1960 x 1897 pixels — 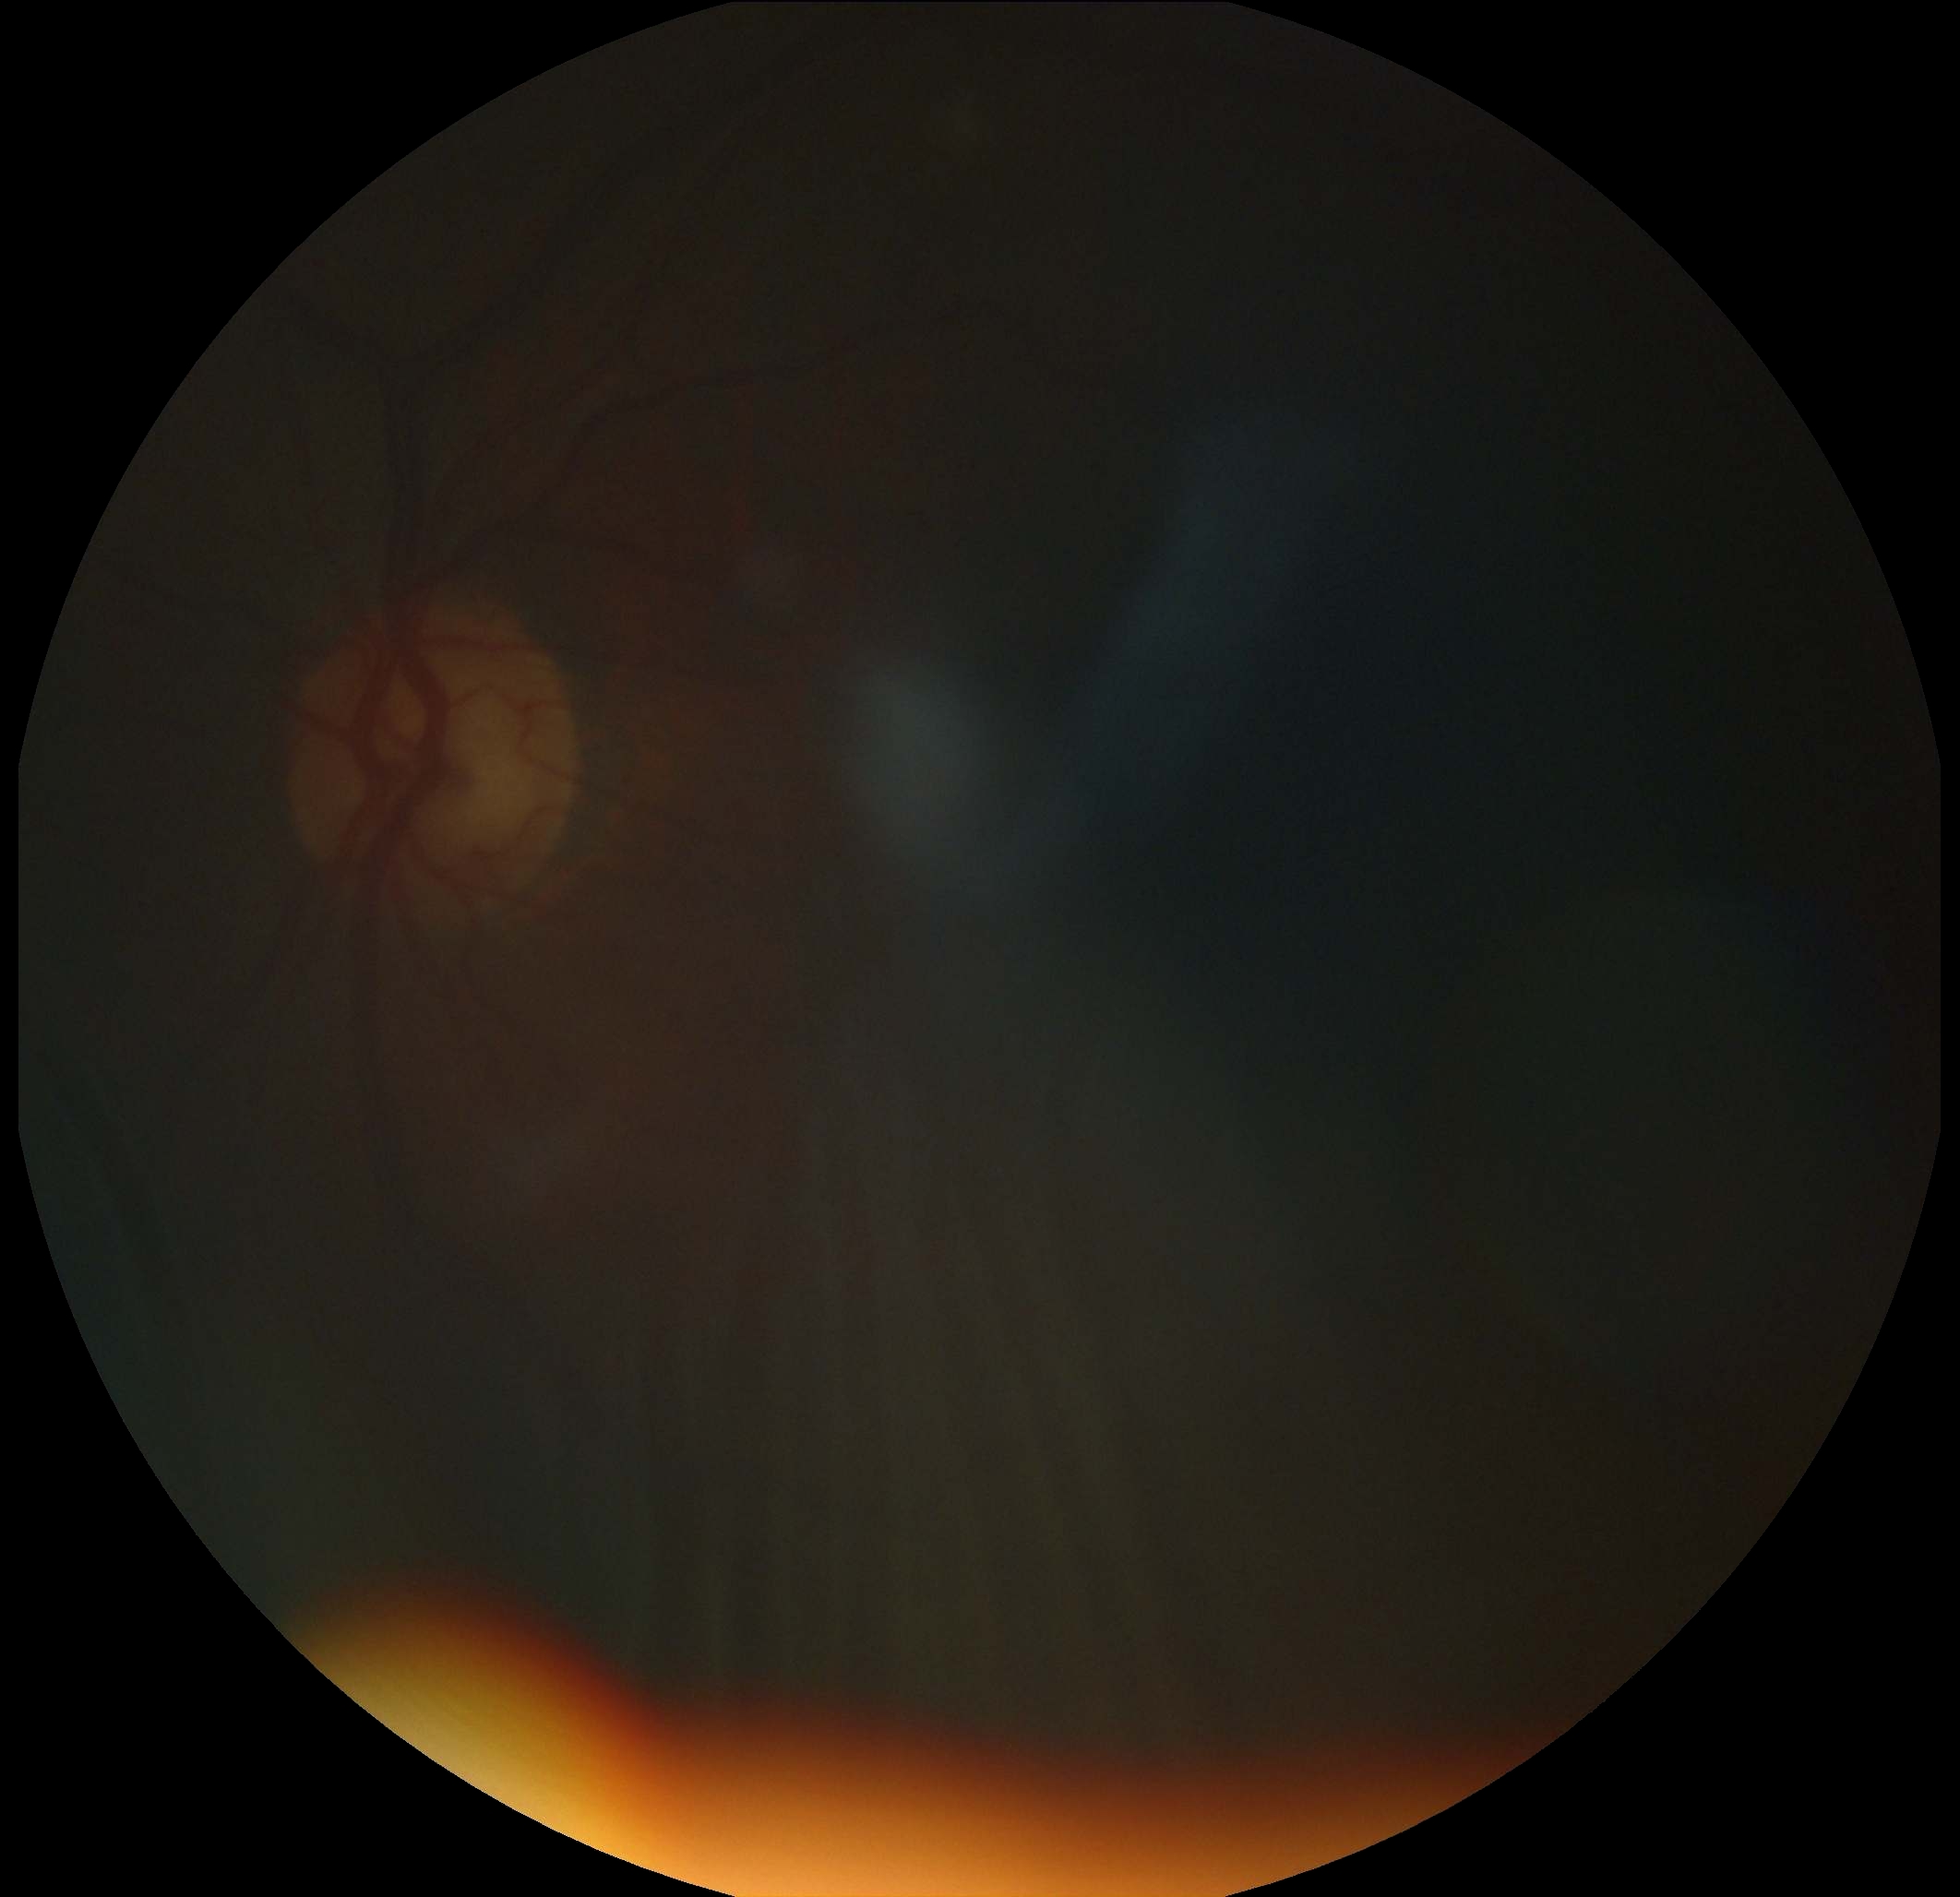 Diabetic retinopathy (DR): ungradable.